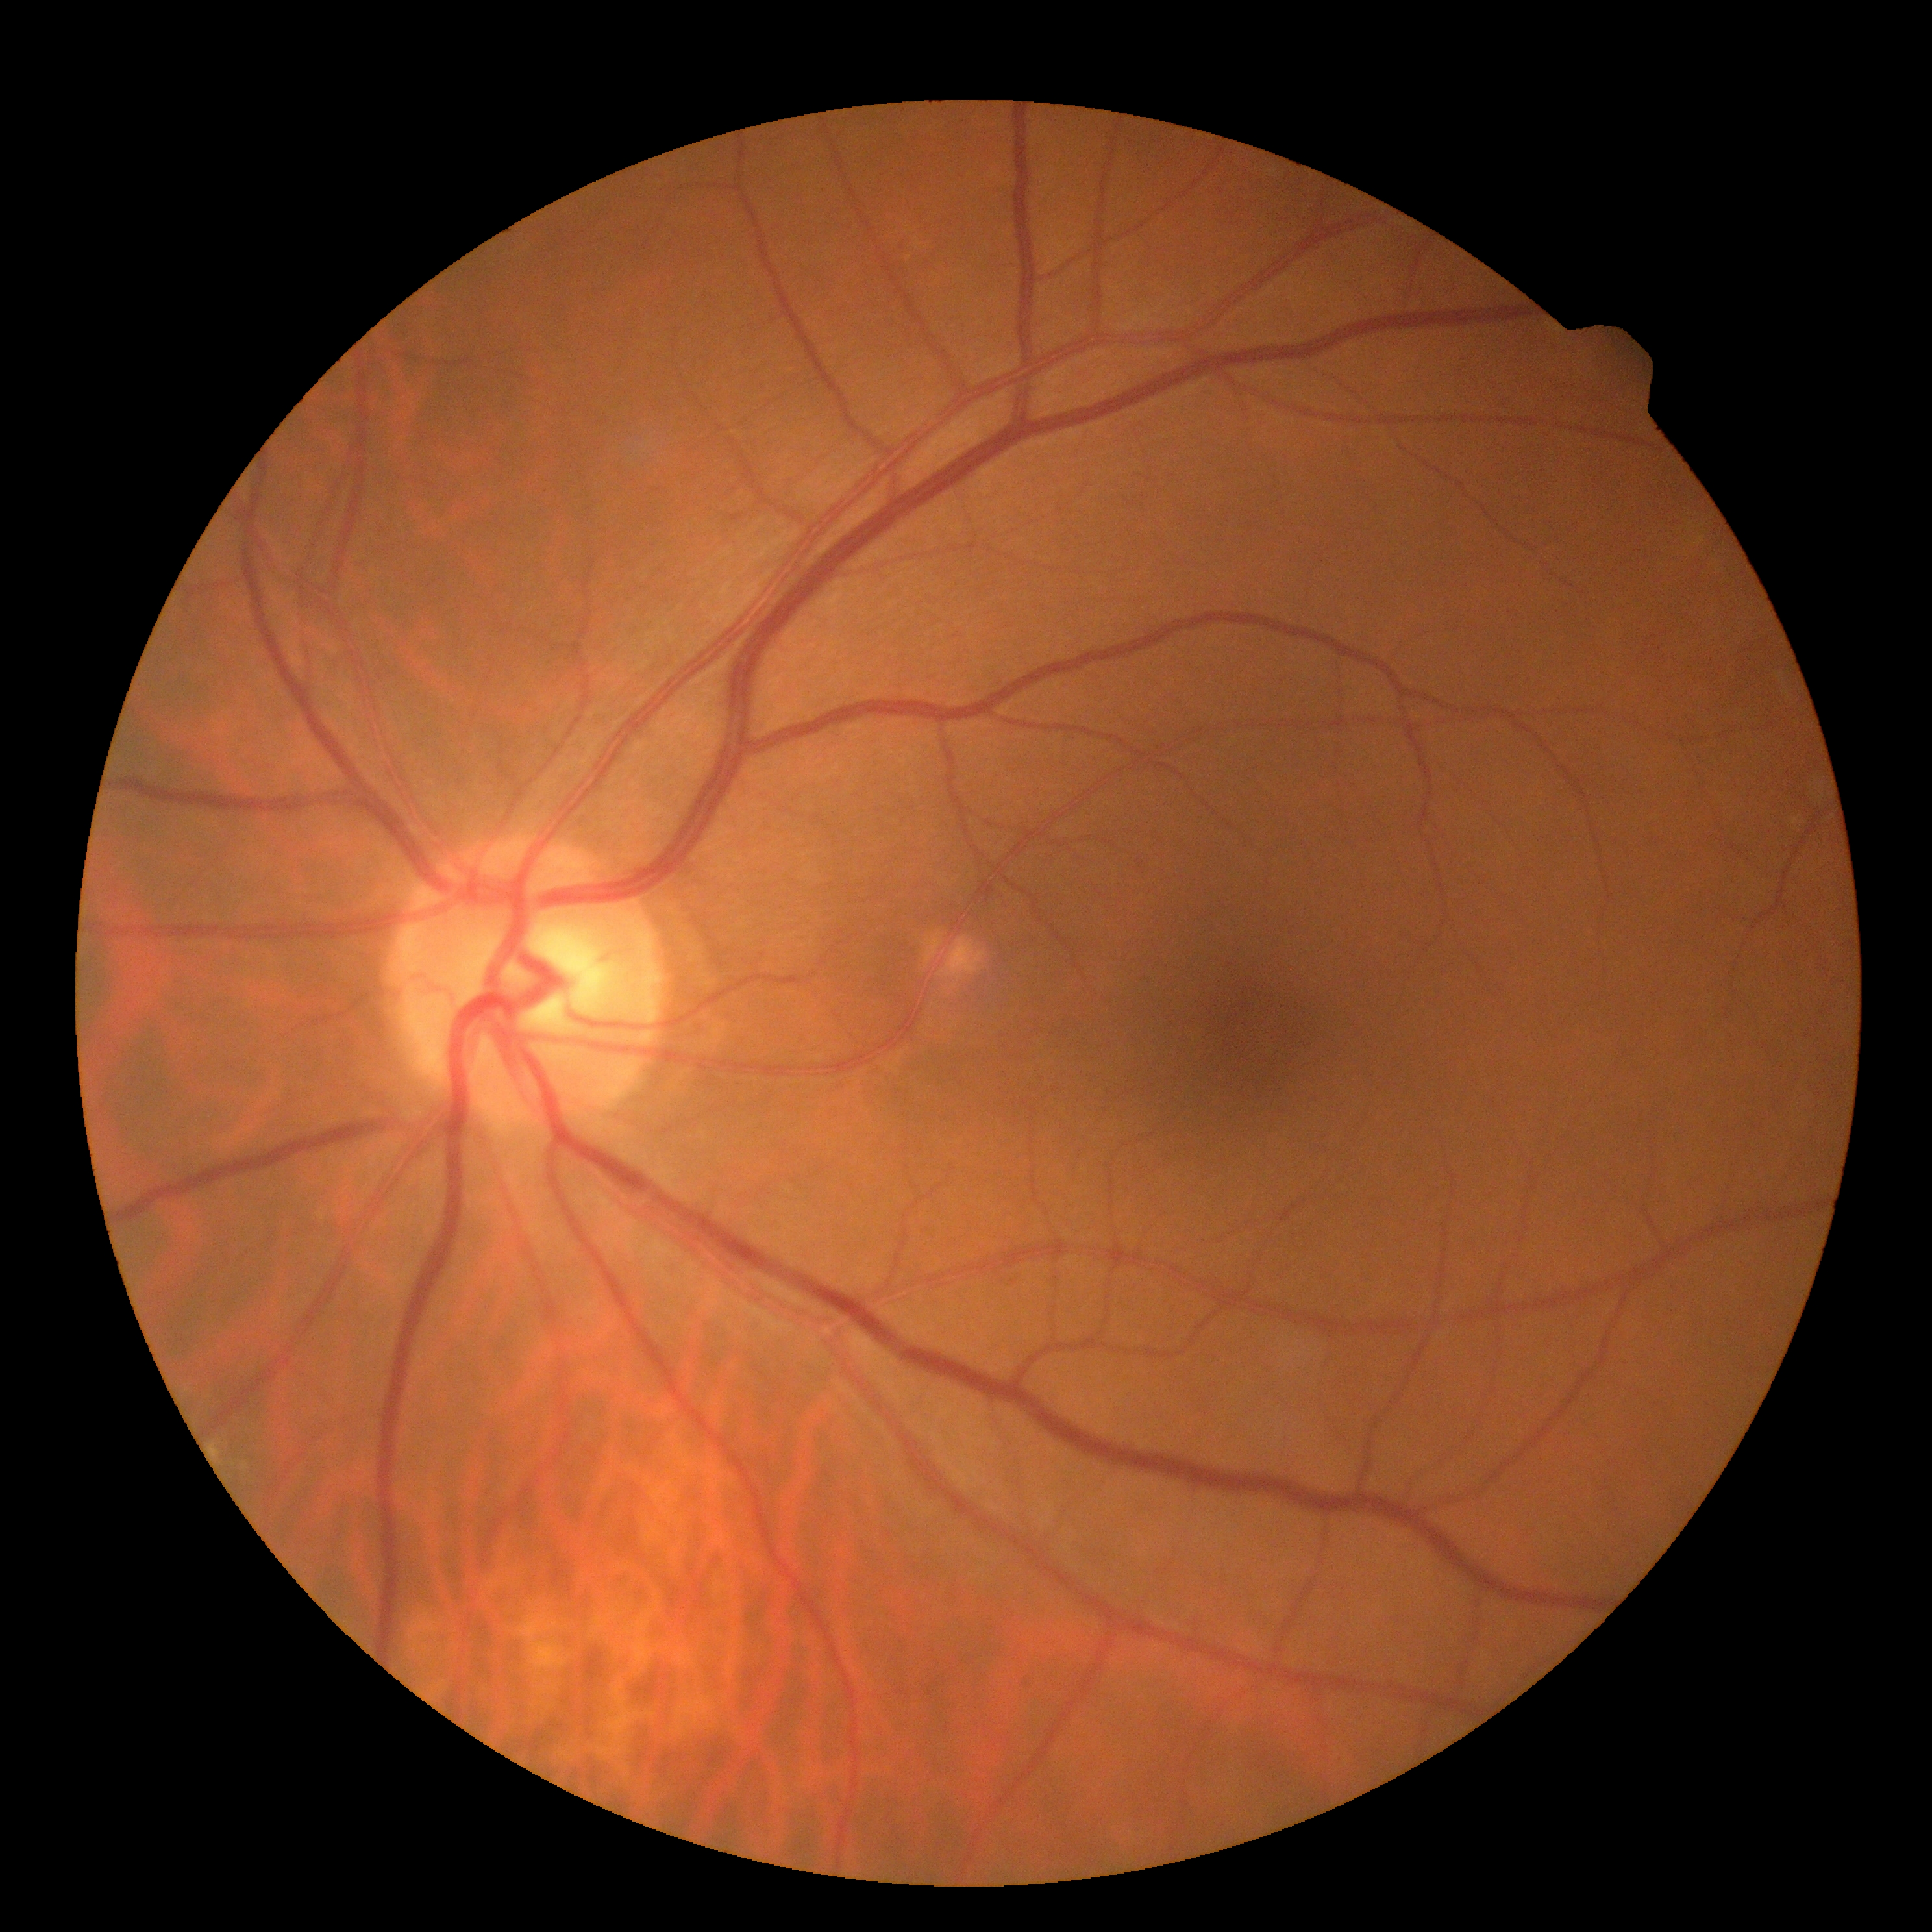
Annotations:
- DR severity — 0